Wide-field fundus image from infant ROP screening · captured with the Phoenix ICON (100° field of view):
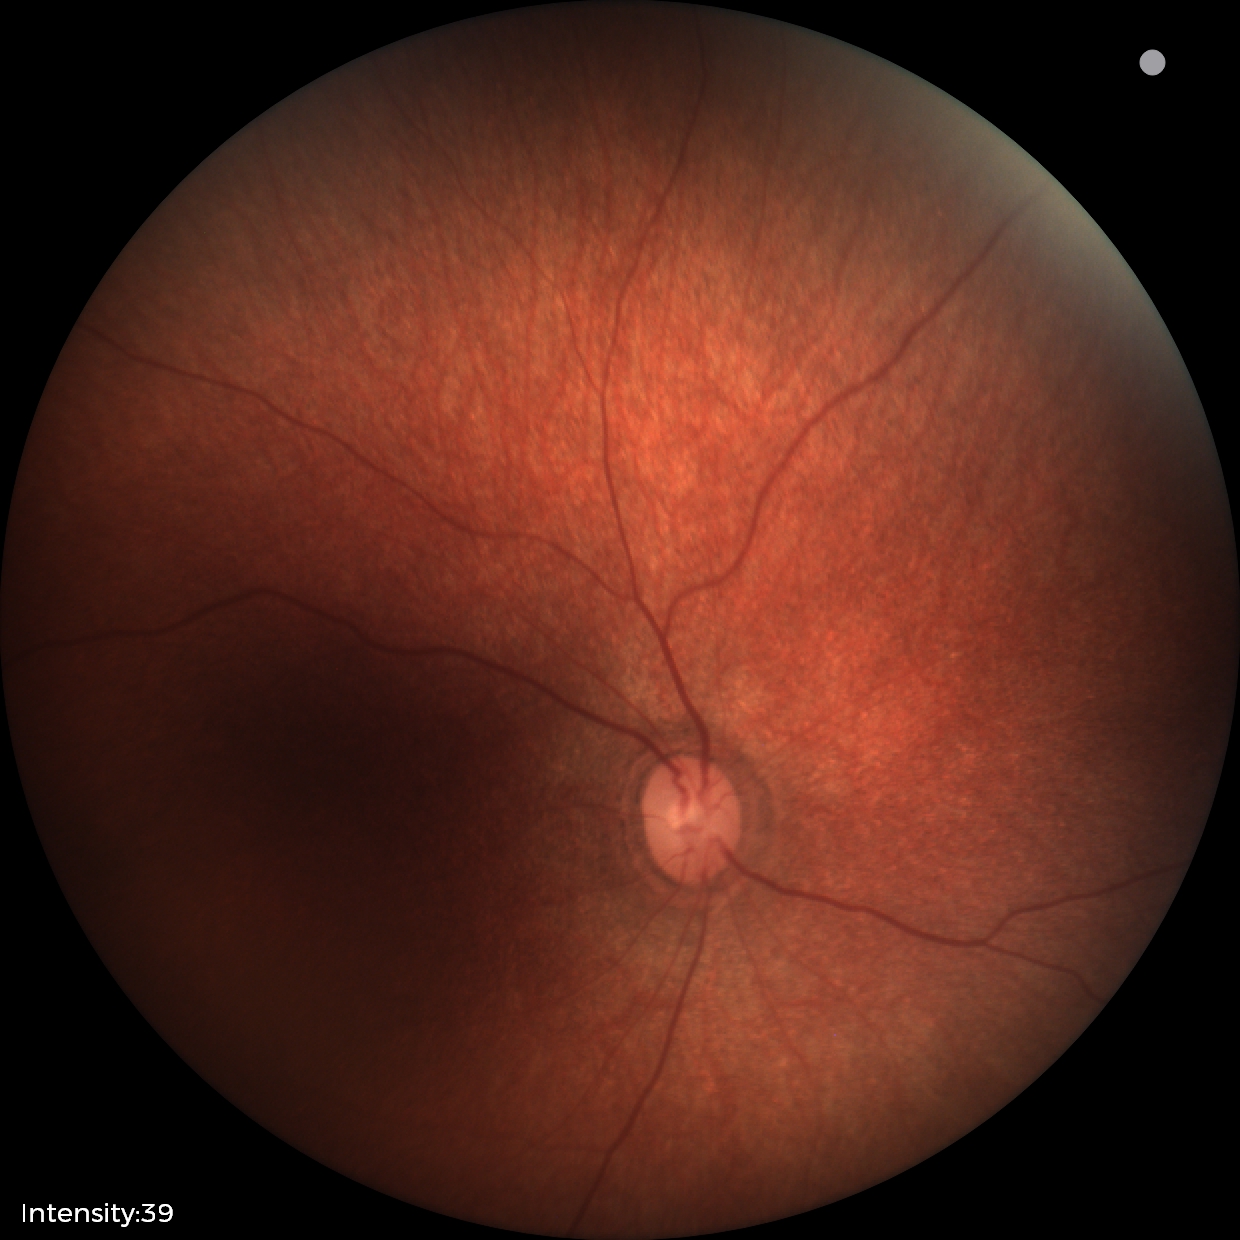 Screening examination diagnosed as physiological.